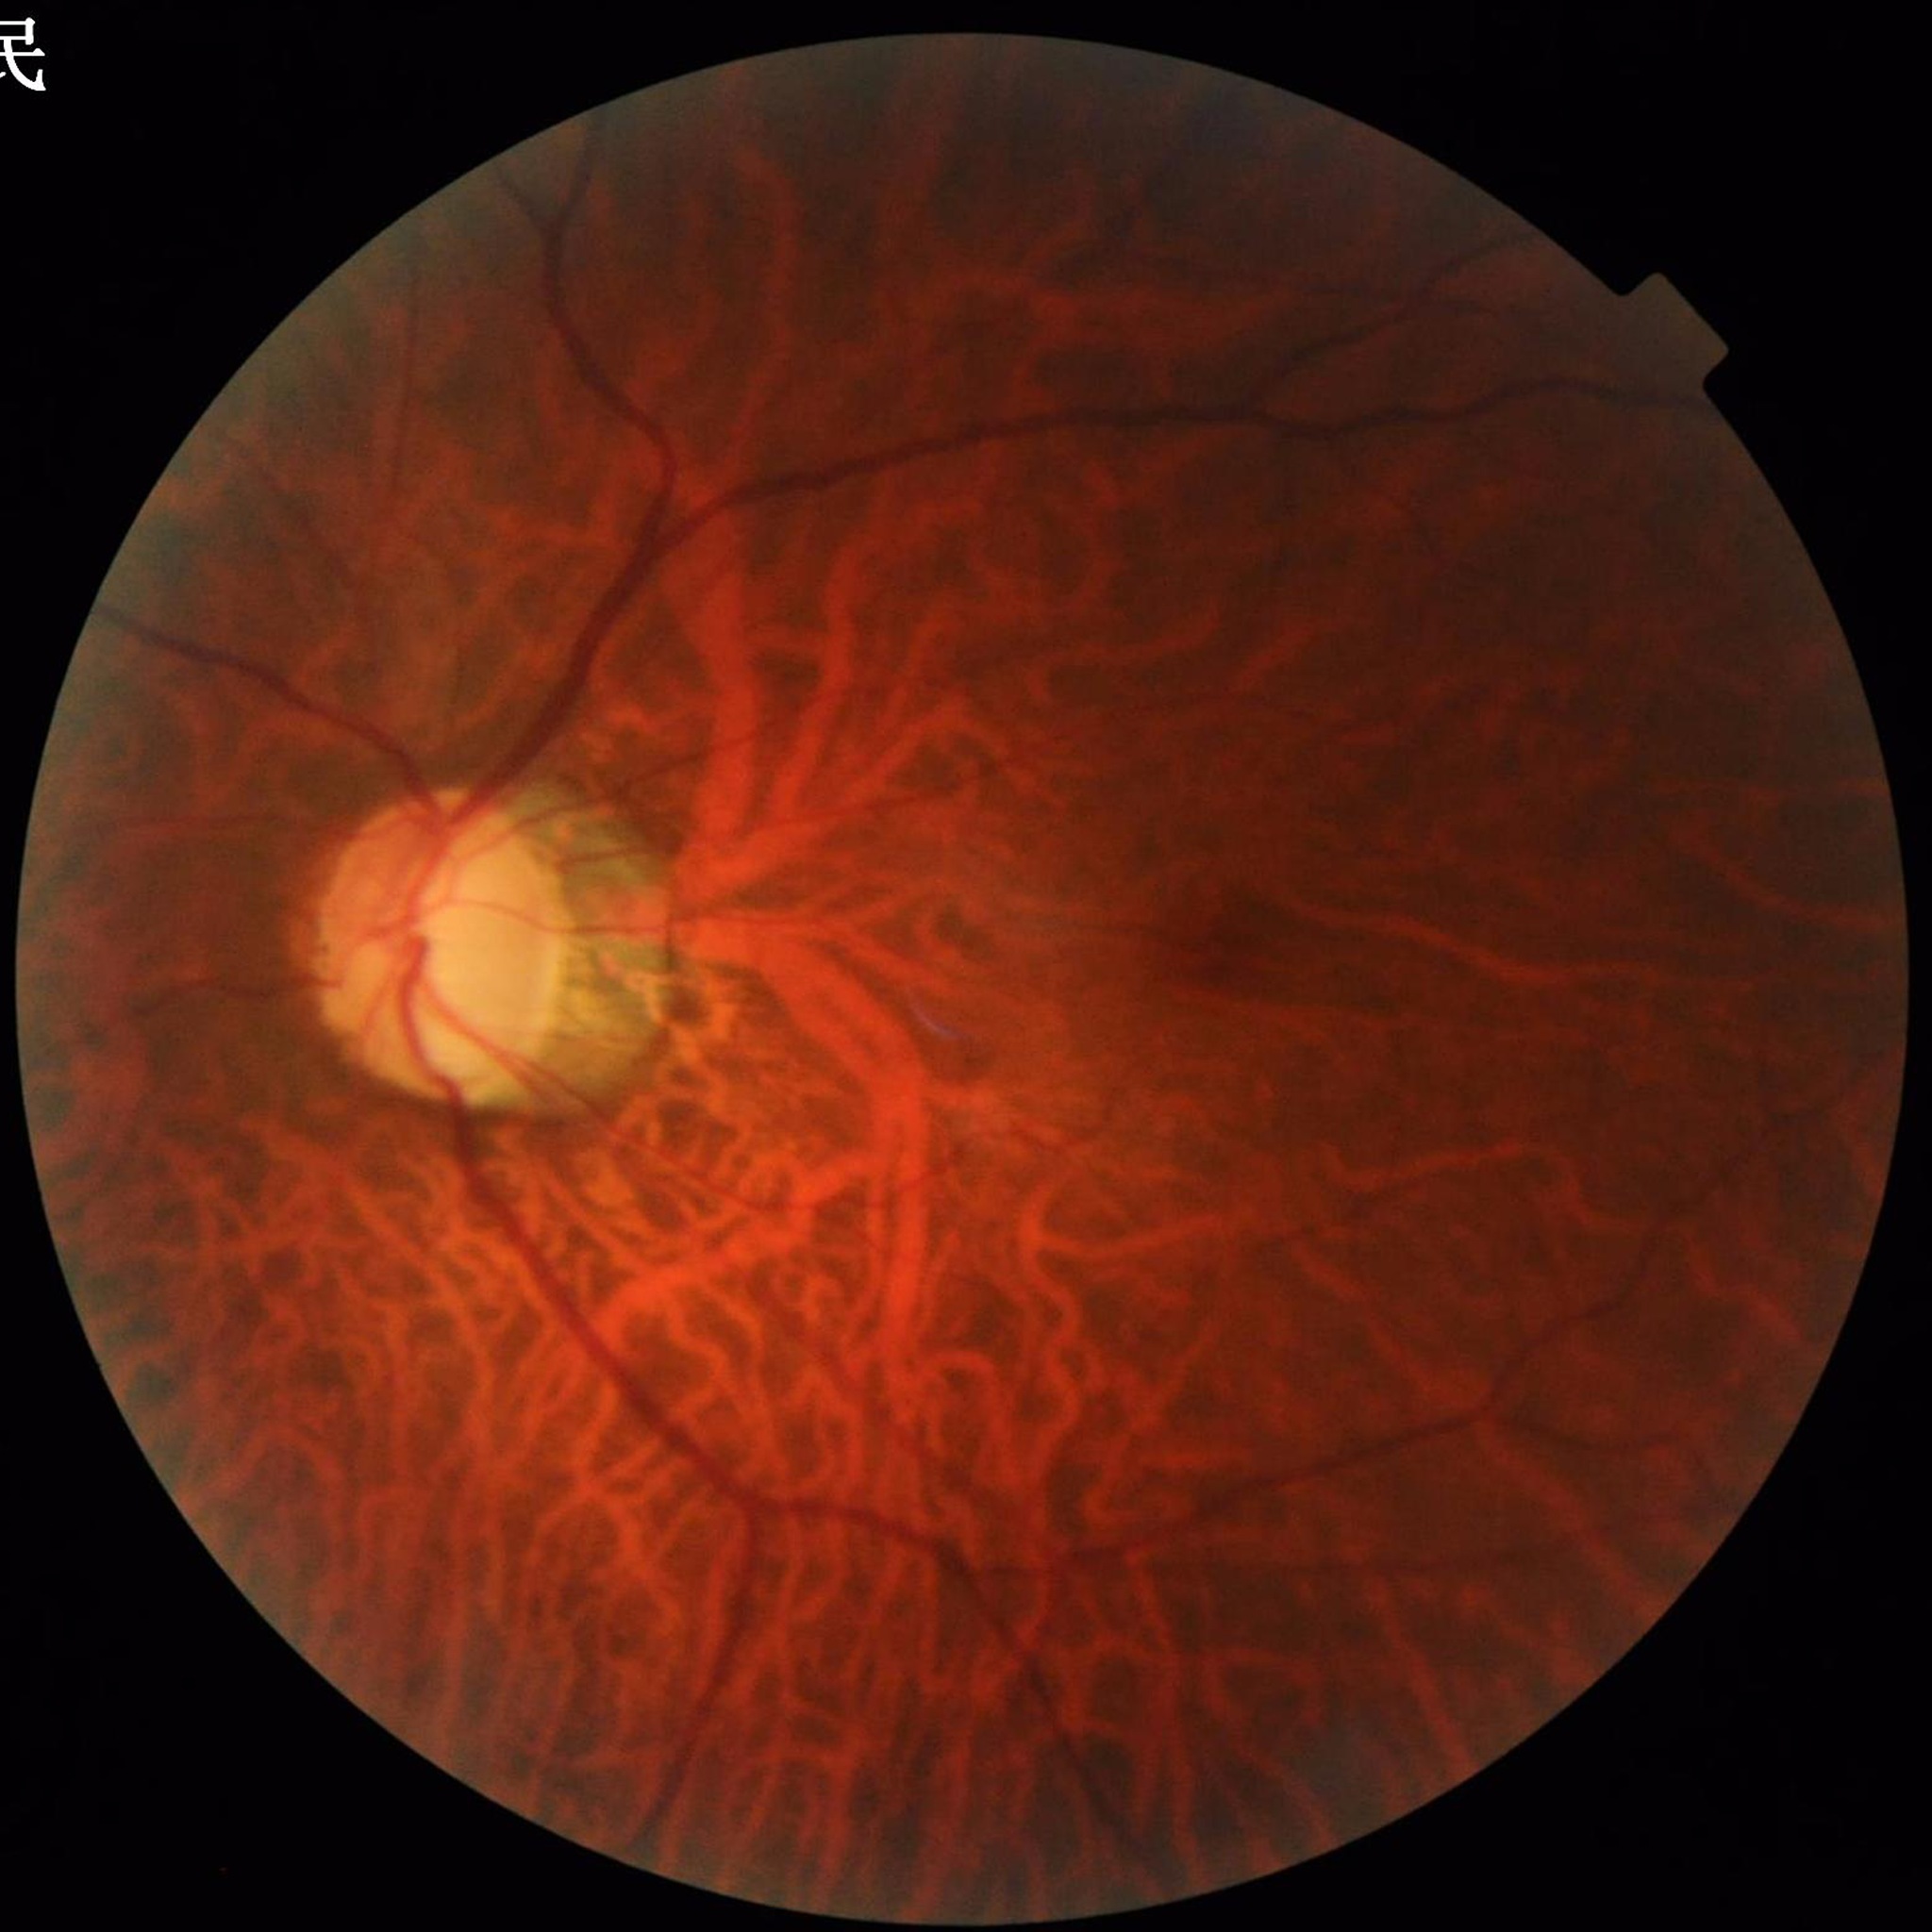   diagnosis: glaucoma